2352x1568px — 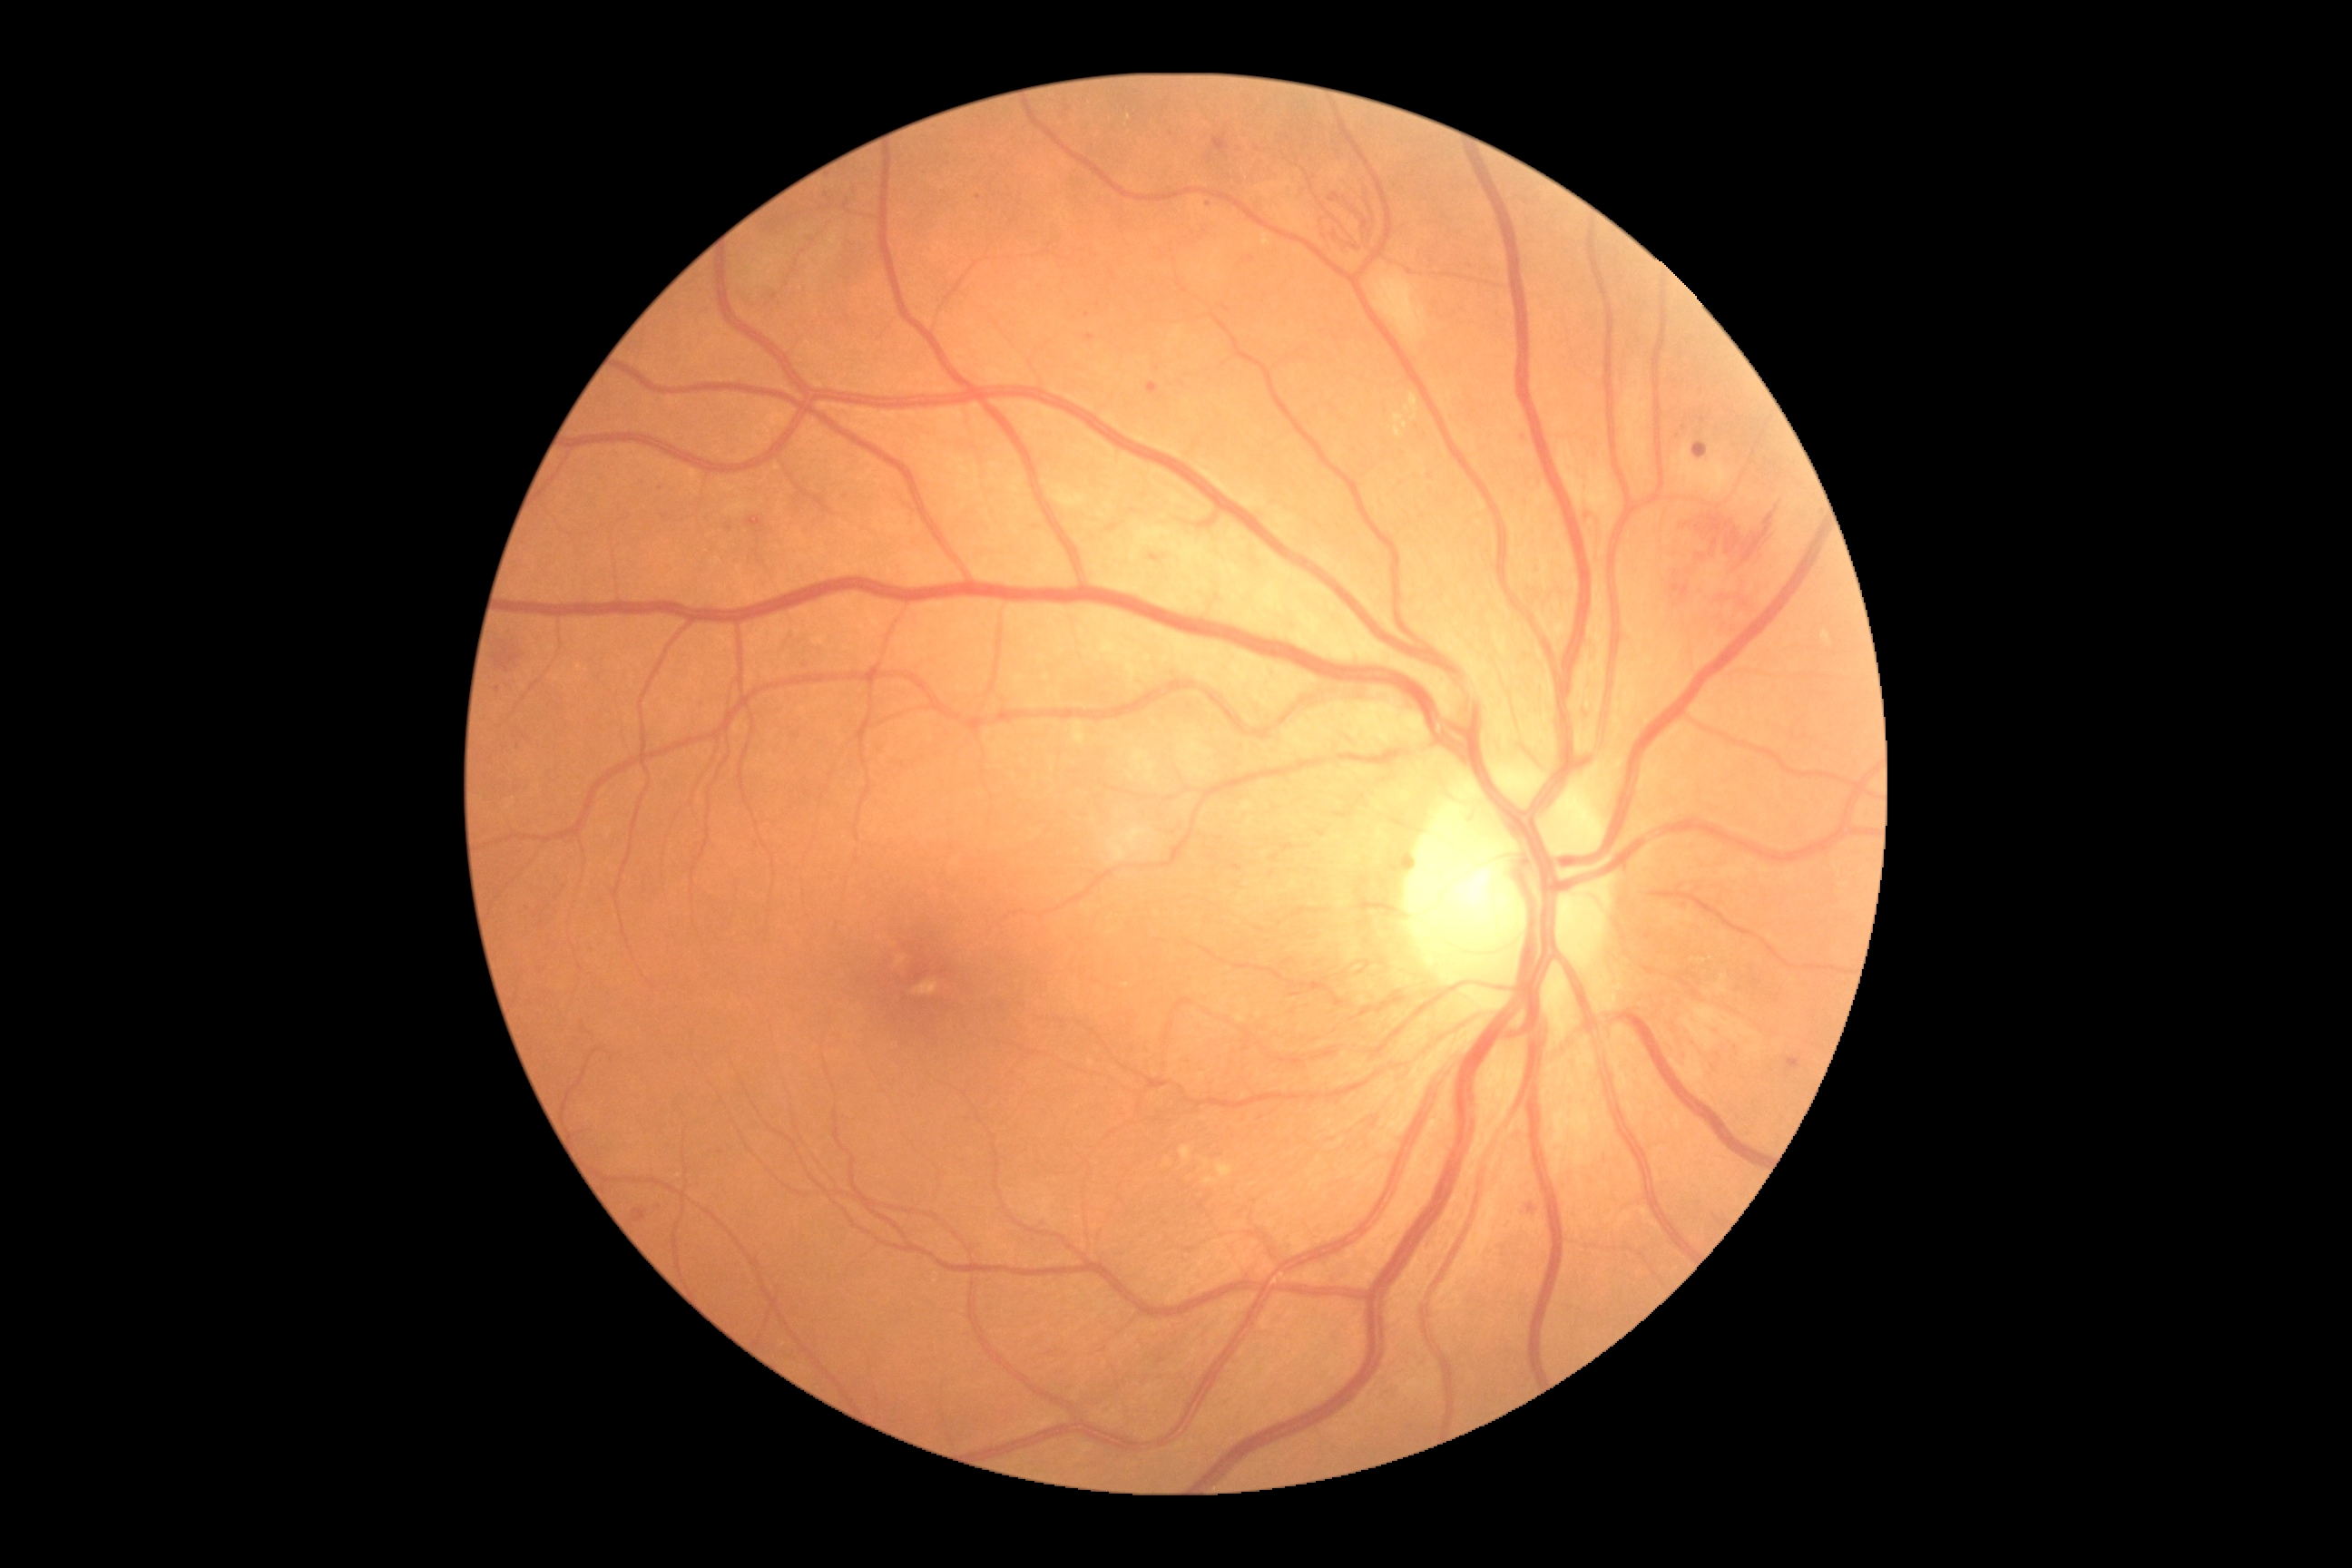
DR severity: 3/4.